Ultra-widefield (UWF) fundus image: 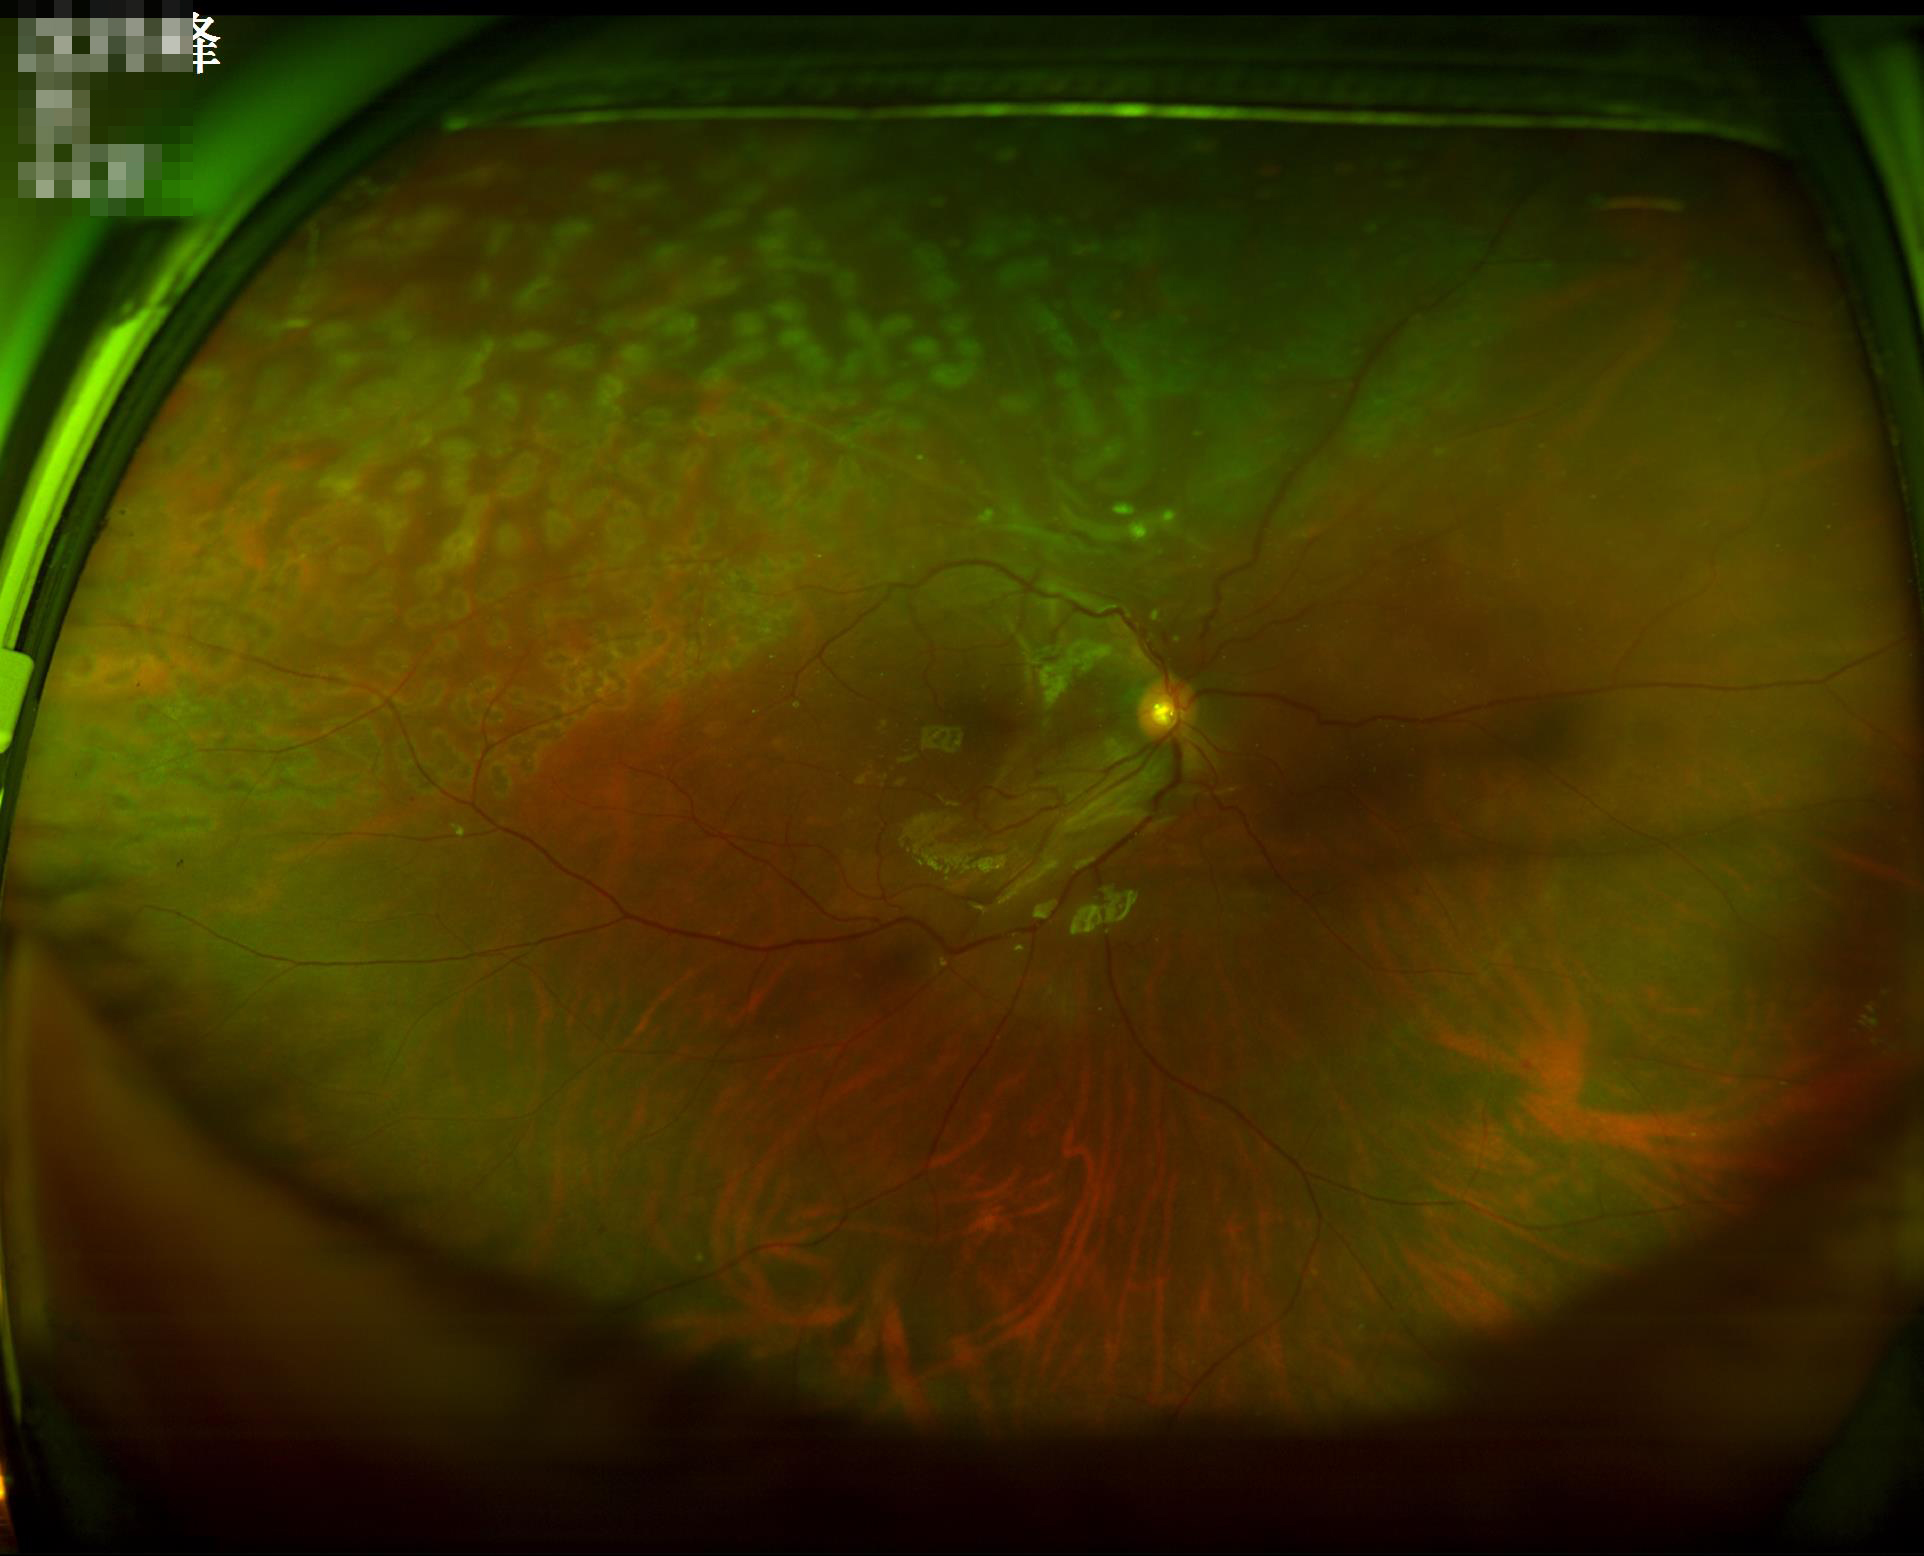

Sharpness = clear | Overall image quality = low | Illumination/color = suboptimal.